CFP — 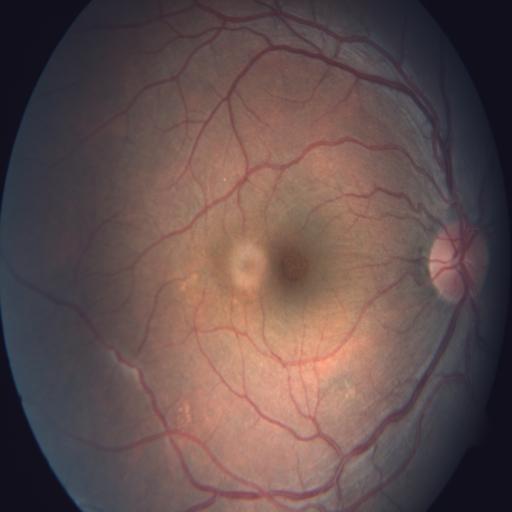
Abnormalities: macular hole.